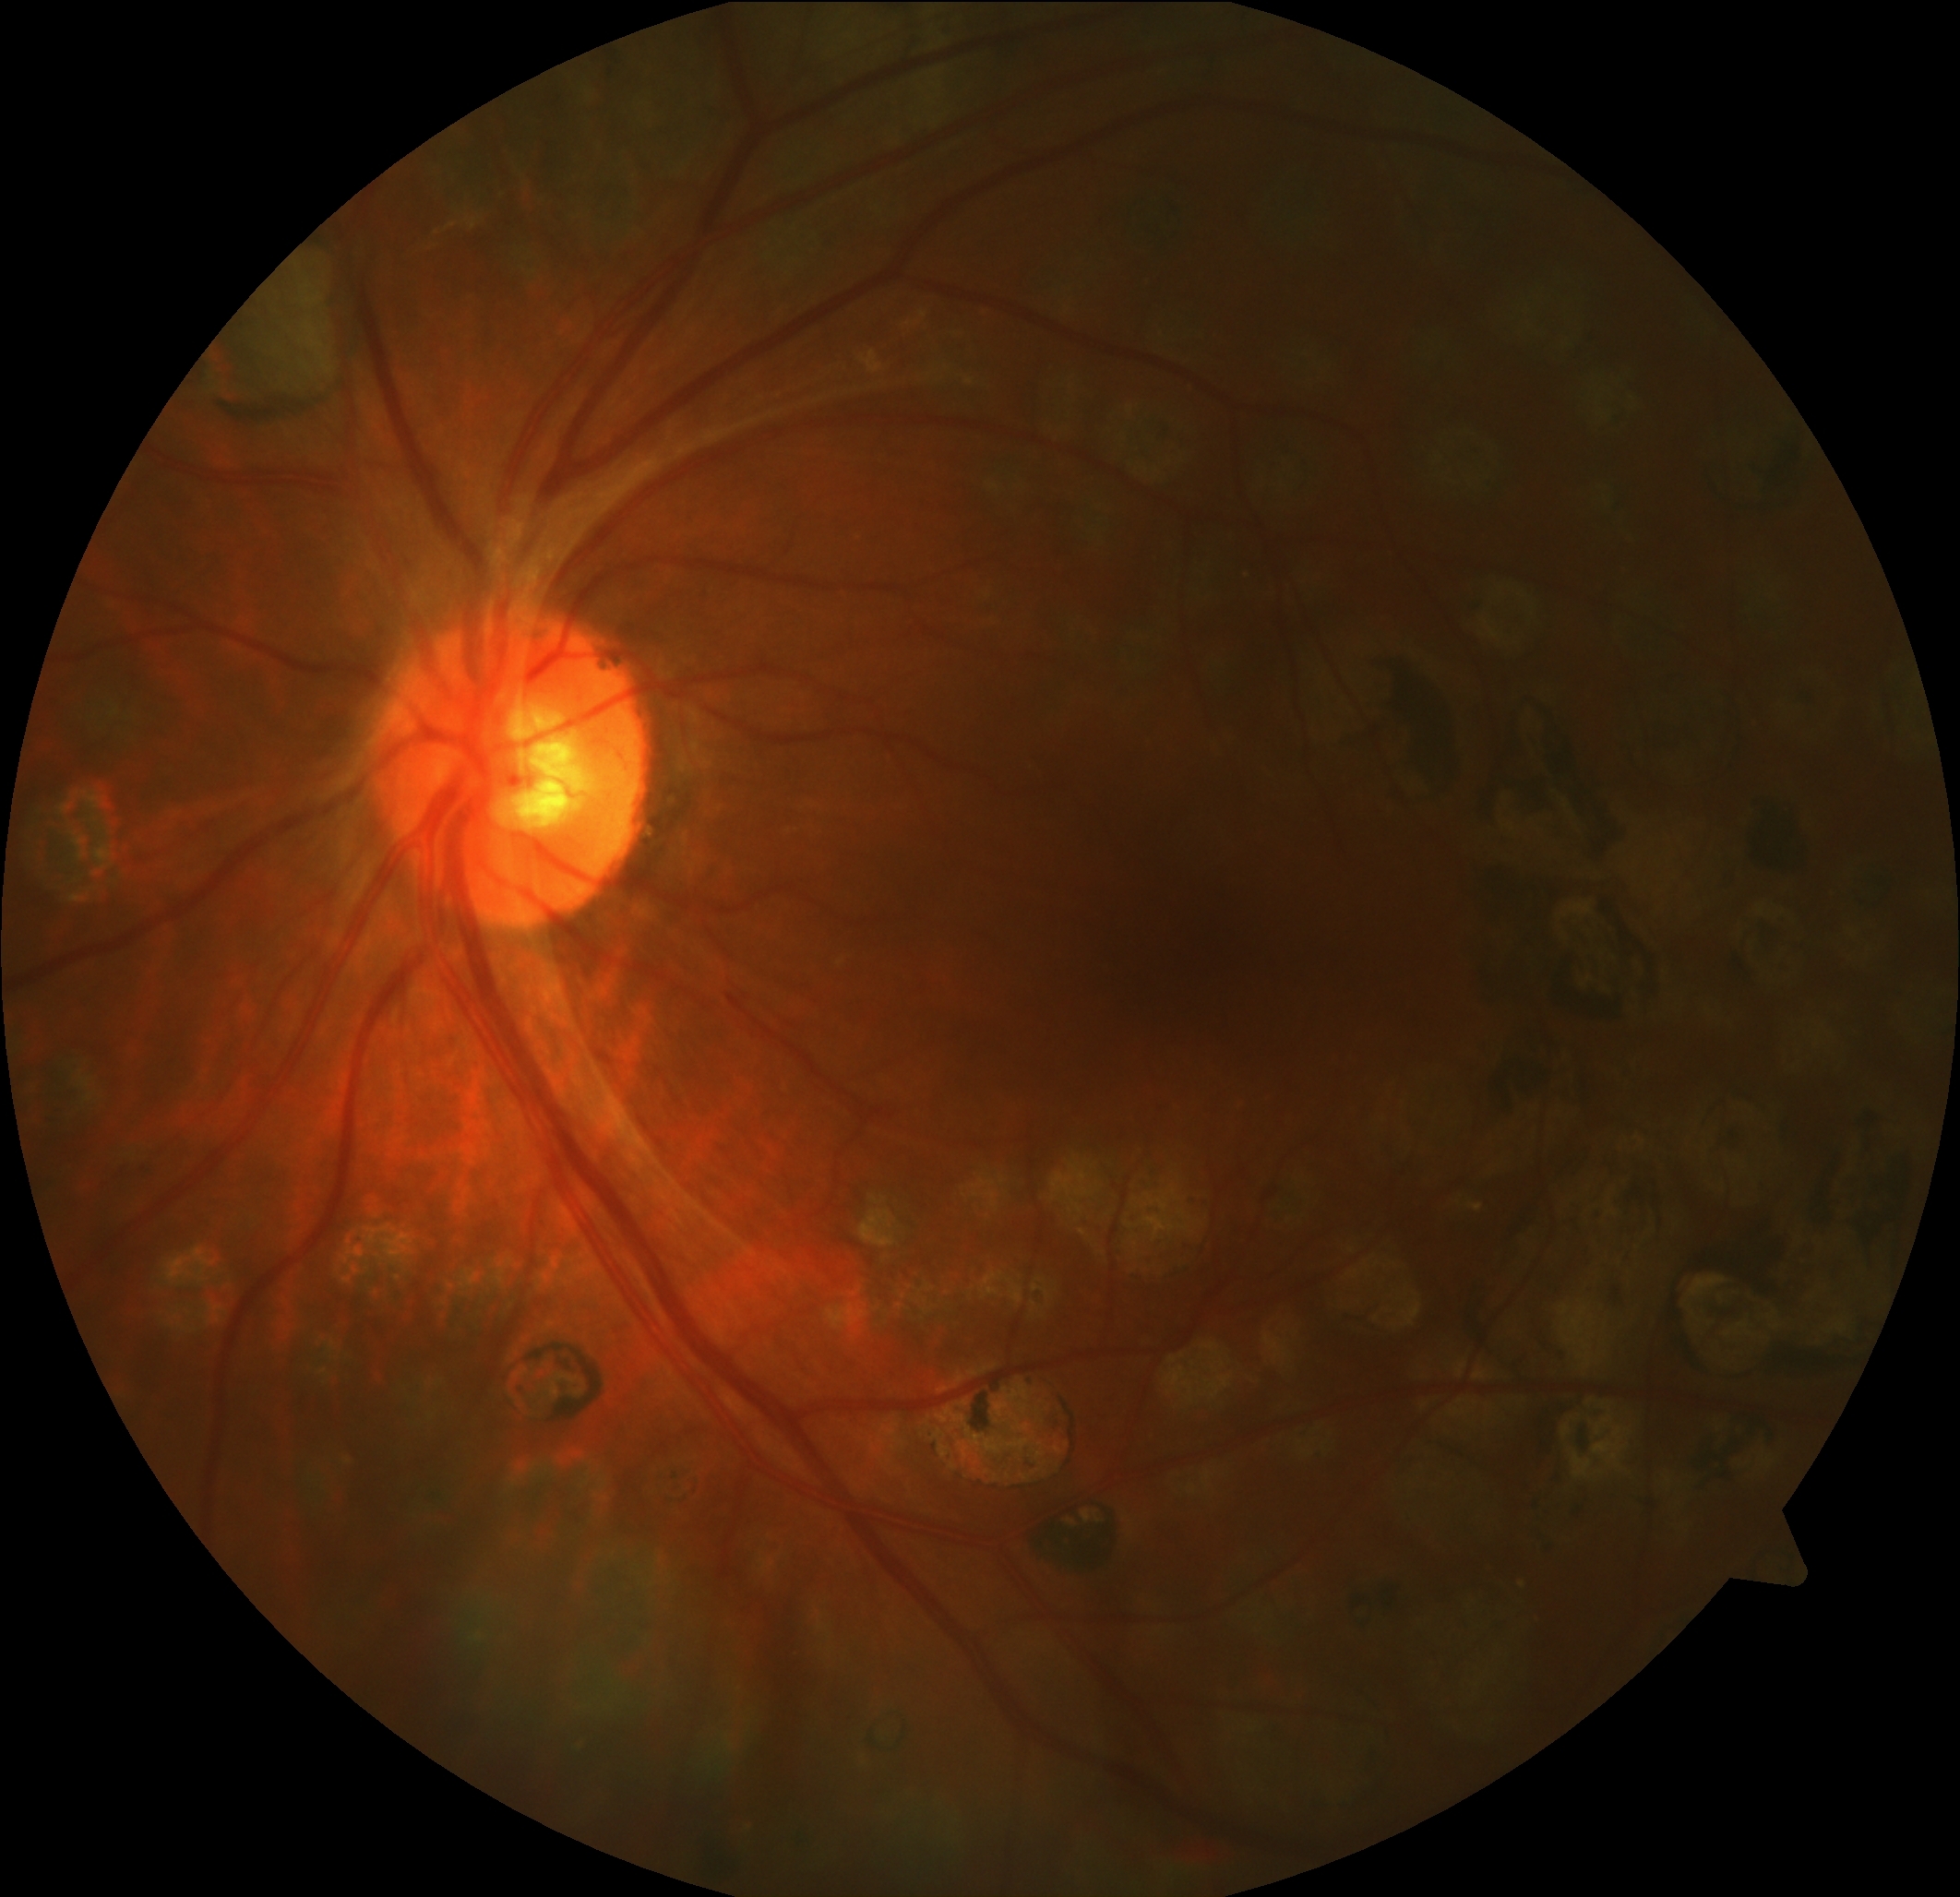
{
  "dr_grade": "grade 4"
}